Pediatric retinal photograph (wide-field)
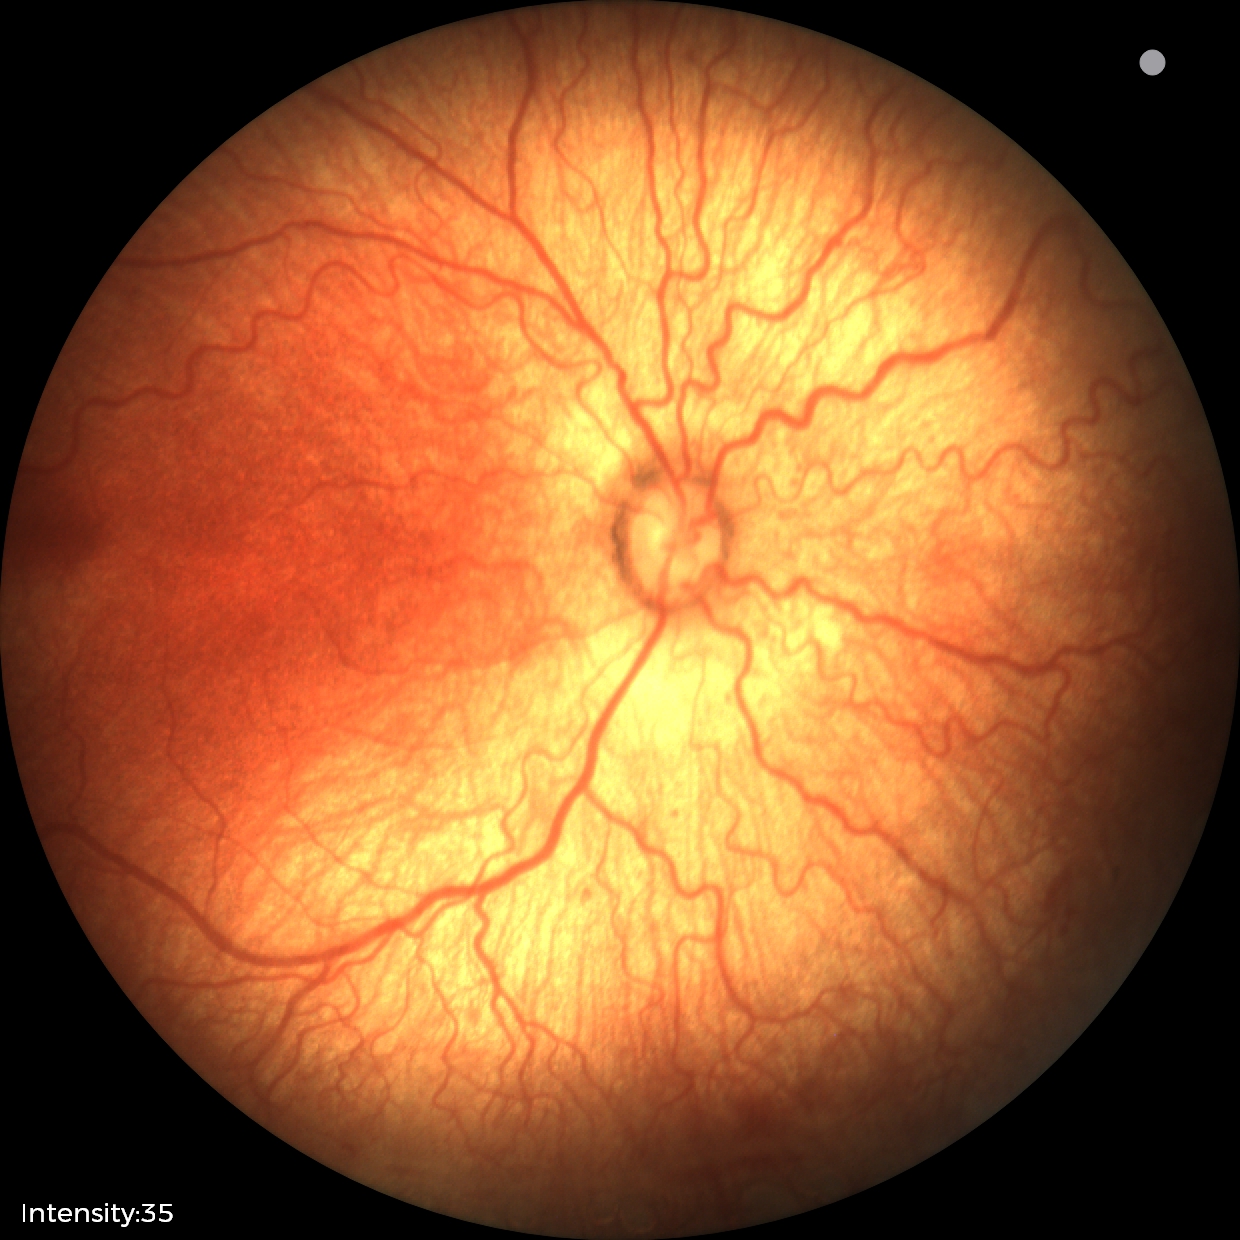 From an examination with diagnosis of ROP stage 2 — ridge with height and width at the demarcation line. Plus disease was diagnosed.